1240x1240. Pediatric wide-field fundus photograph — 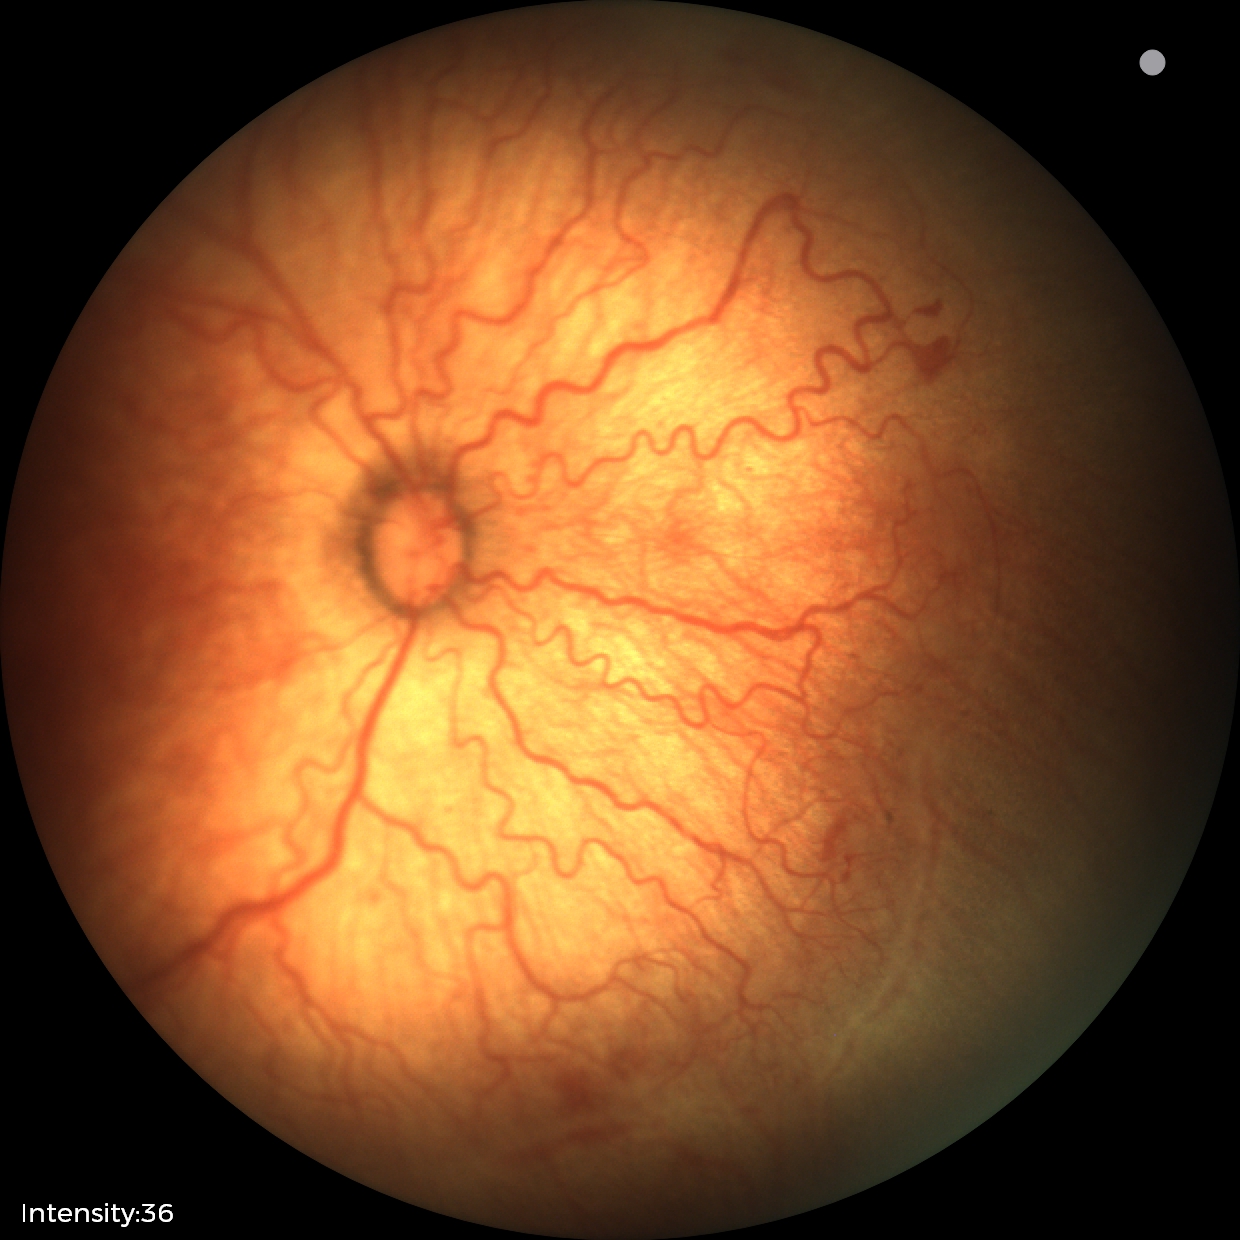
Screening: retinopathy of prematurity stage 2; plus disease.